Modified Davis grading: 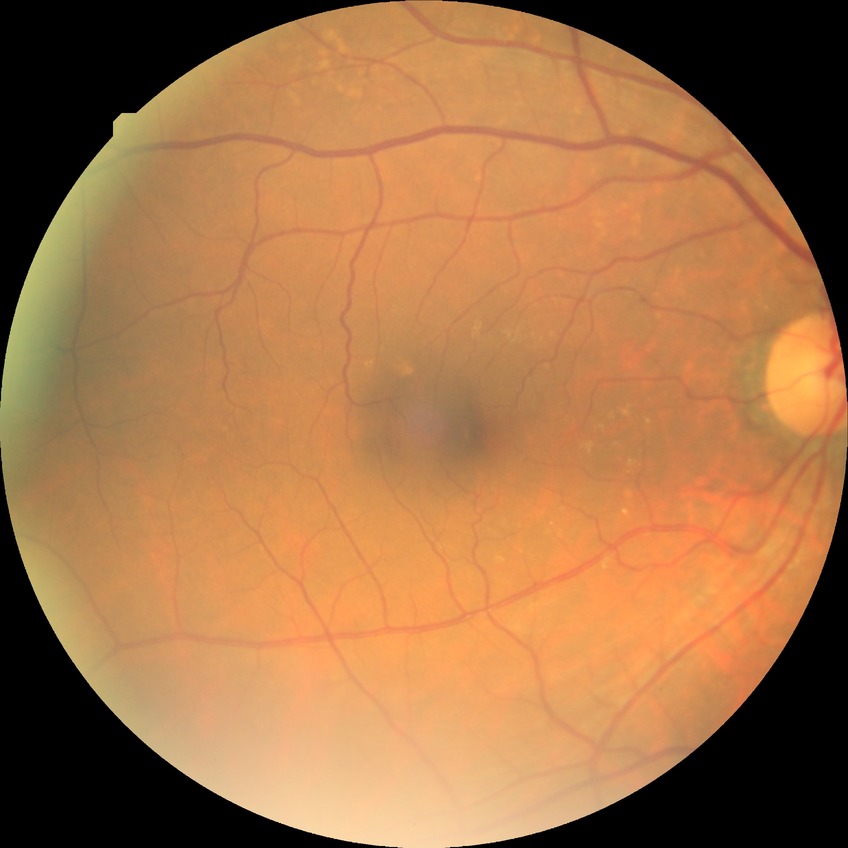

Diabetic retinopathy (DR) is no diabetic retinopathy (NDR).